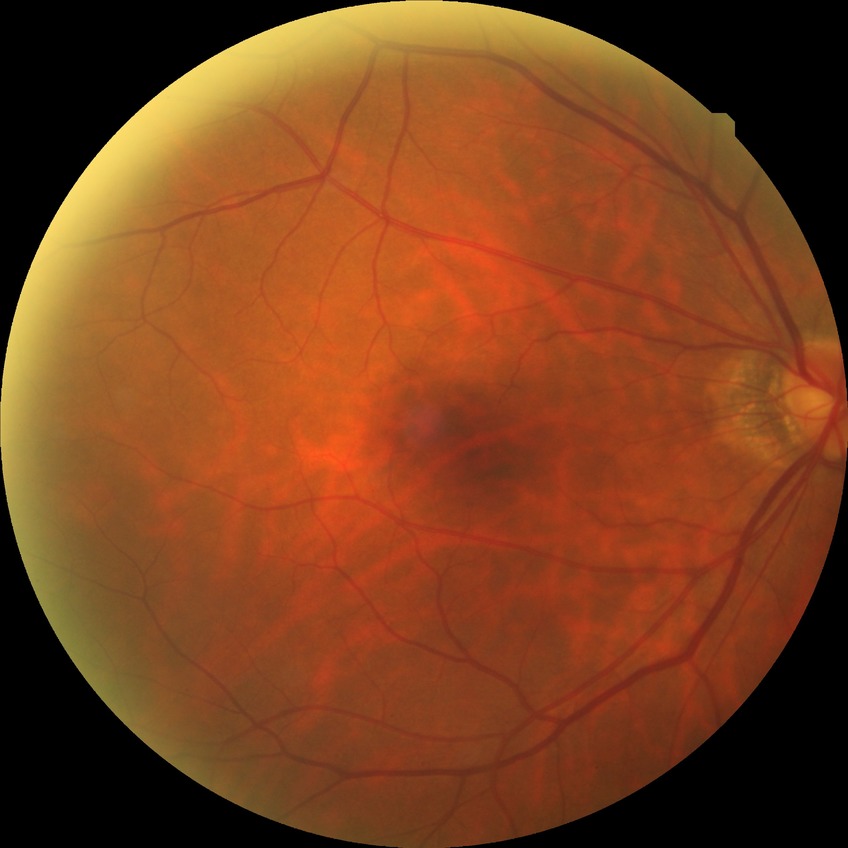
diabetic retinopathy (DR): NDR (no diabetic retinopathy).